640 by 480 pixels; wide-field contact fundus photograph of an infant; 130° field of view (Clarity RetCam 3): 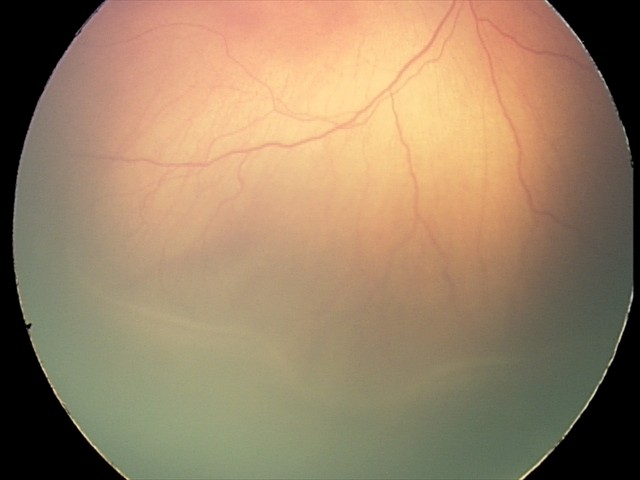

Q: What is the diagnosis from this examination?
A: retinopathy of prematurity stage 2